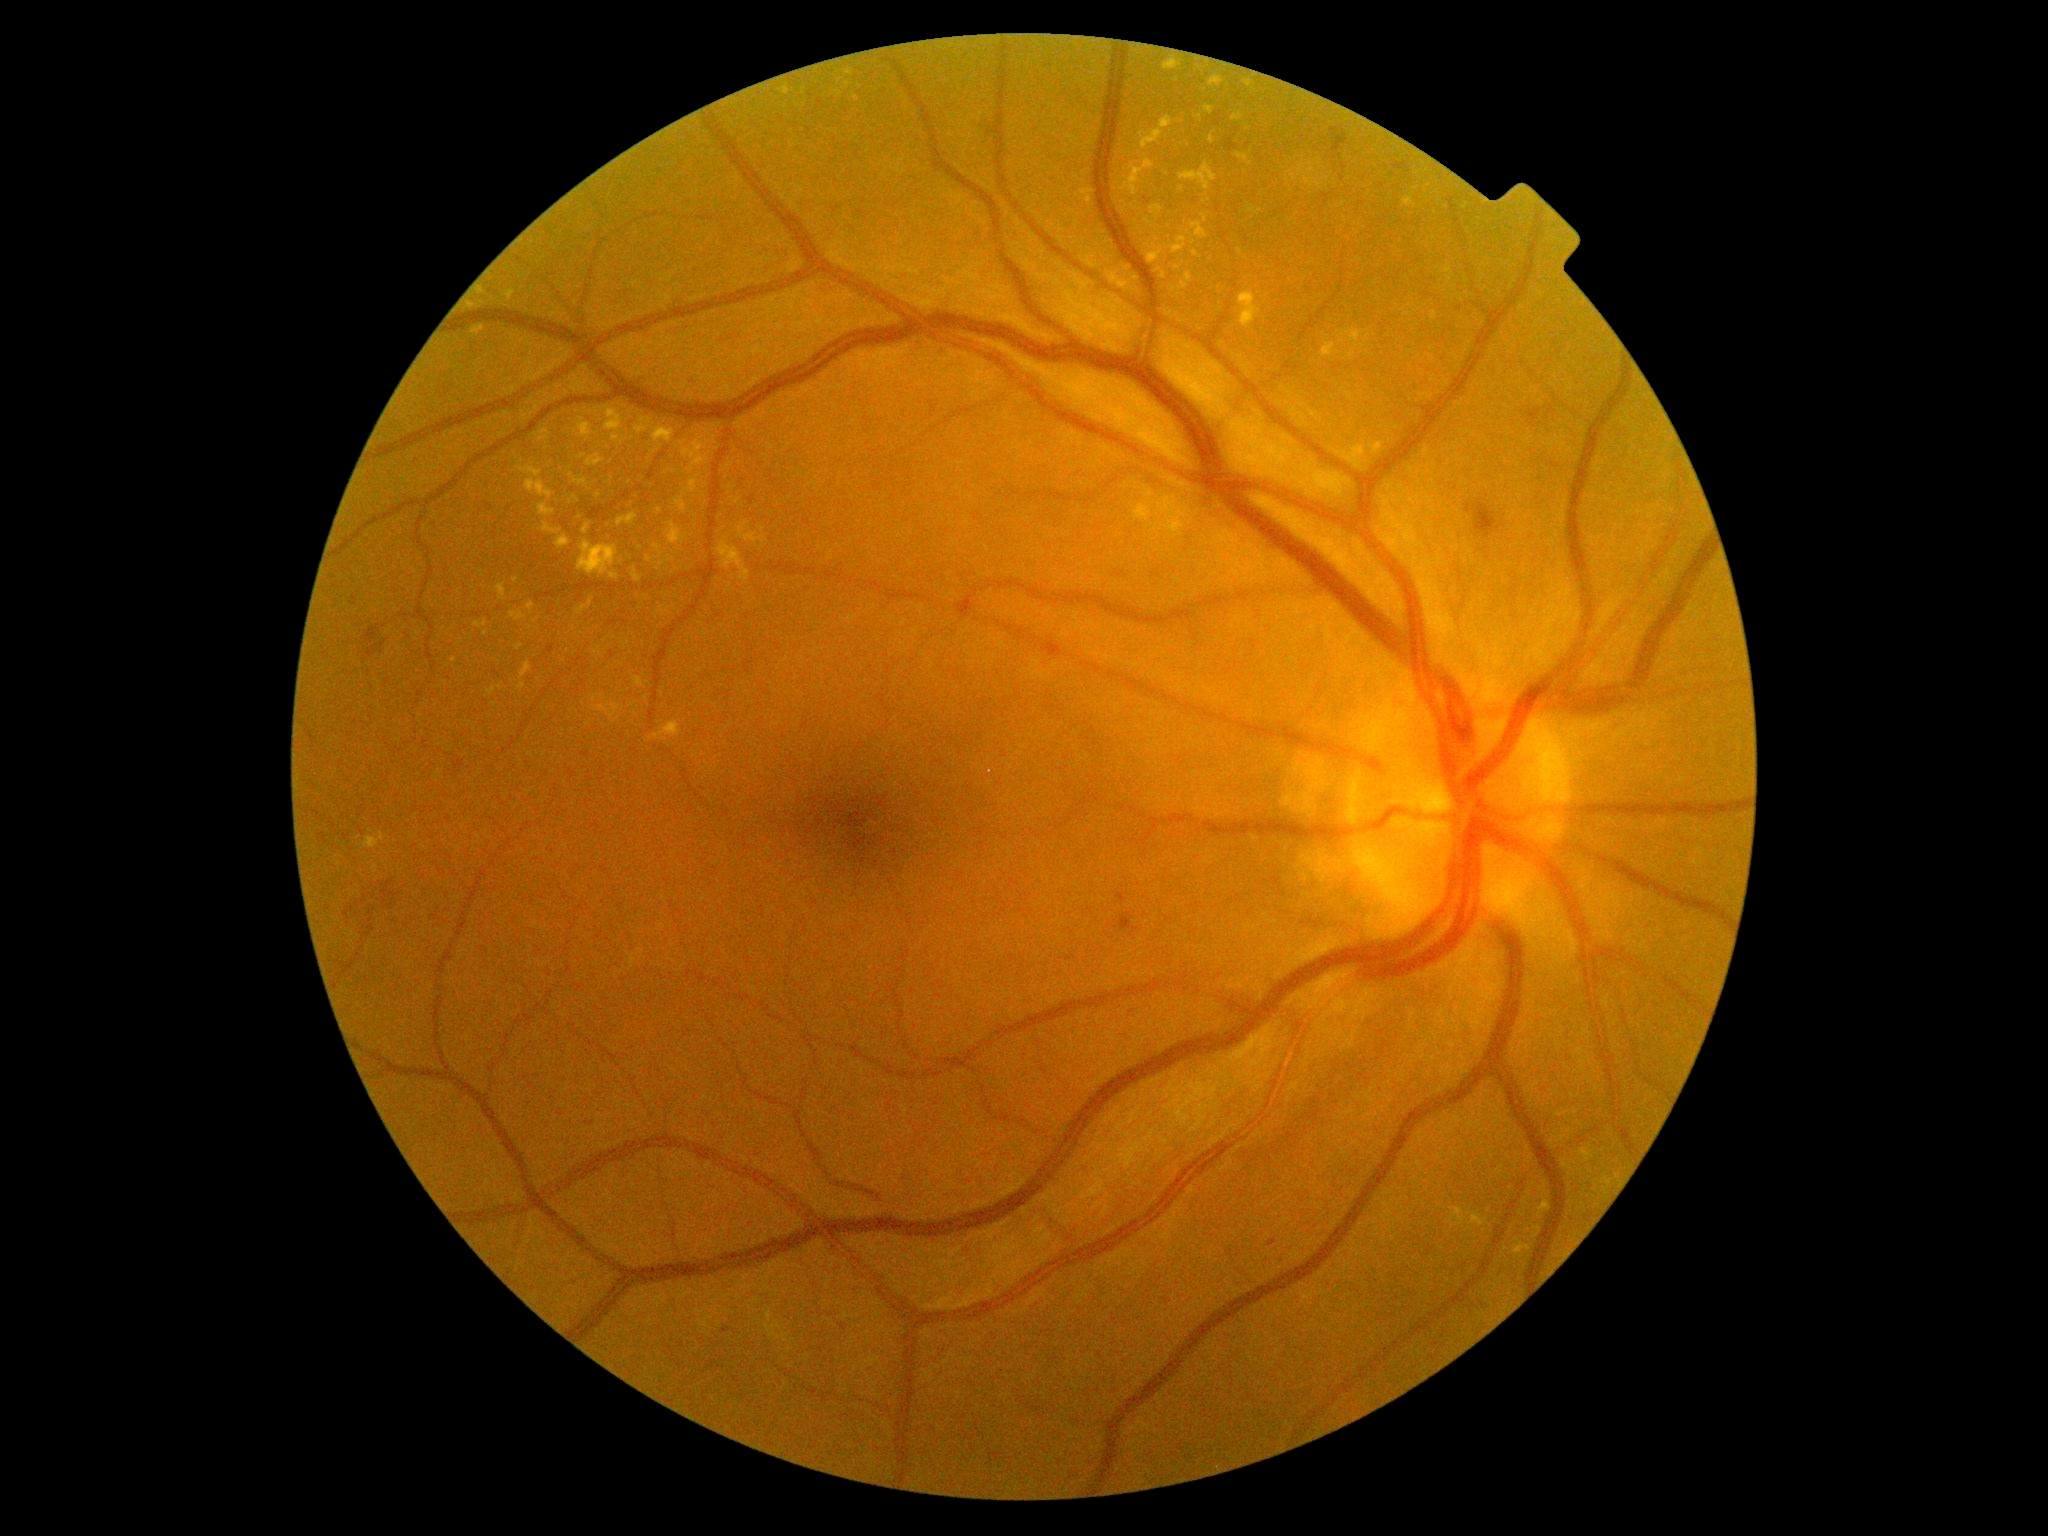
Diabetic retinopathy (DR): grade 2
Representative lesions:
- hard exudates (EXs) (partial): (617,512,638,527); (1193,251,1202,260); (1348,350,1355,359); (574,417,598,440); (1232,113,1244,122); (472,326,485,339); (1076,188,1094,207); (1239,293,1261,329); (510,611,528,623); (717,538,750,584); (1404,198,1417,208); (667,469,675,475)
- Small EXs near x=516 y=581; x=1201 y=118; x=599 y=496; x=1250 y=164; x=609 y=448; x=1182 y=190; x=640 y=548; x=1137 y=223